RetCam wide-field infant fundus image; acquired on the Clarity RetCam 3:
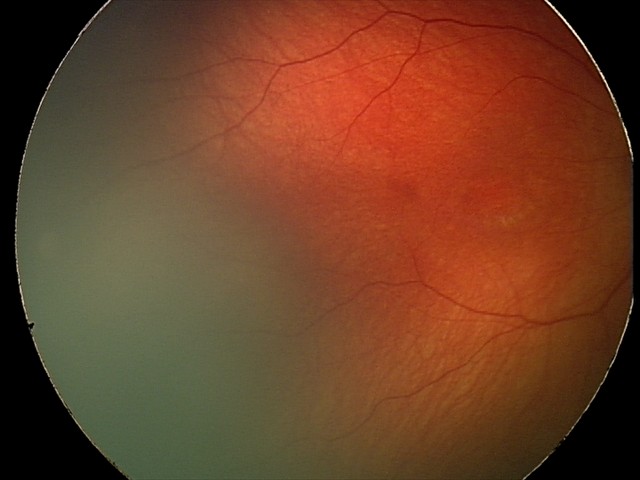 Examination with physiological retinal findings.